1659x2212px.
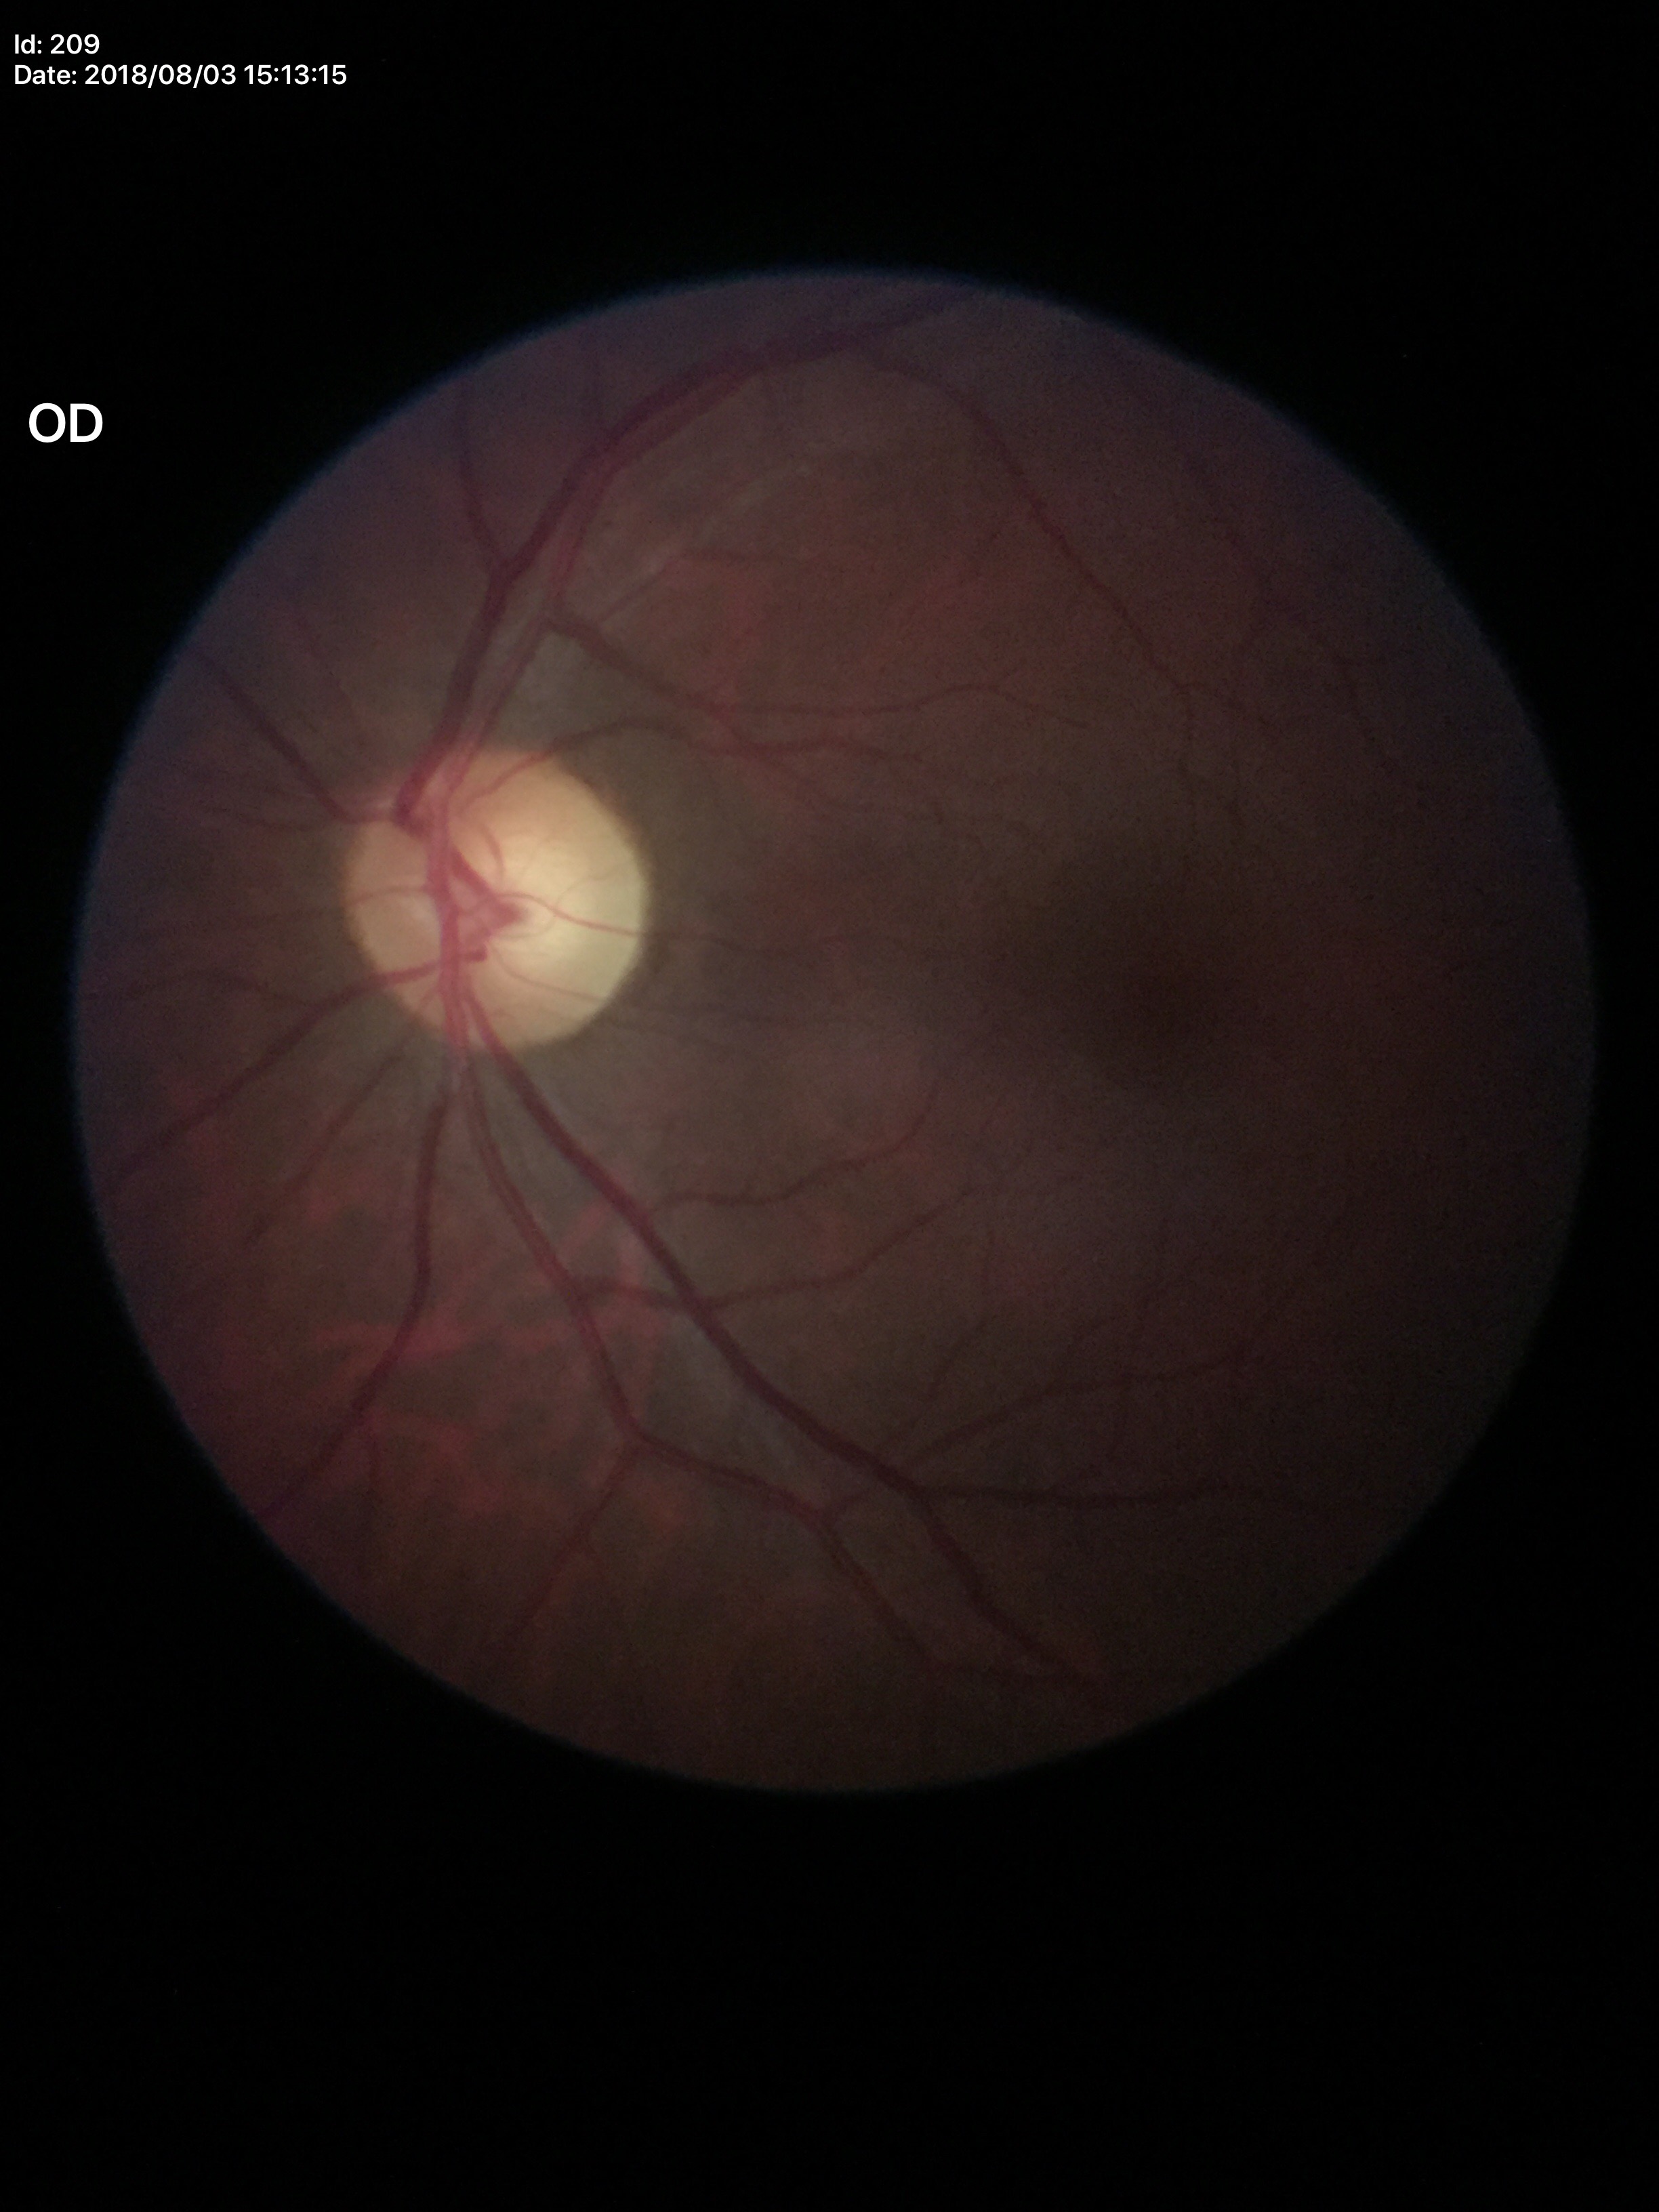

Glaucoma decision: no suspicious findings (5/5 ophthalmologists in agreement). Vertical CDR: 0.54. Horizontal C/D ratio of 0.57.